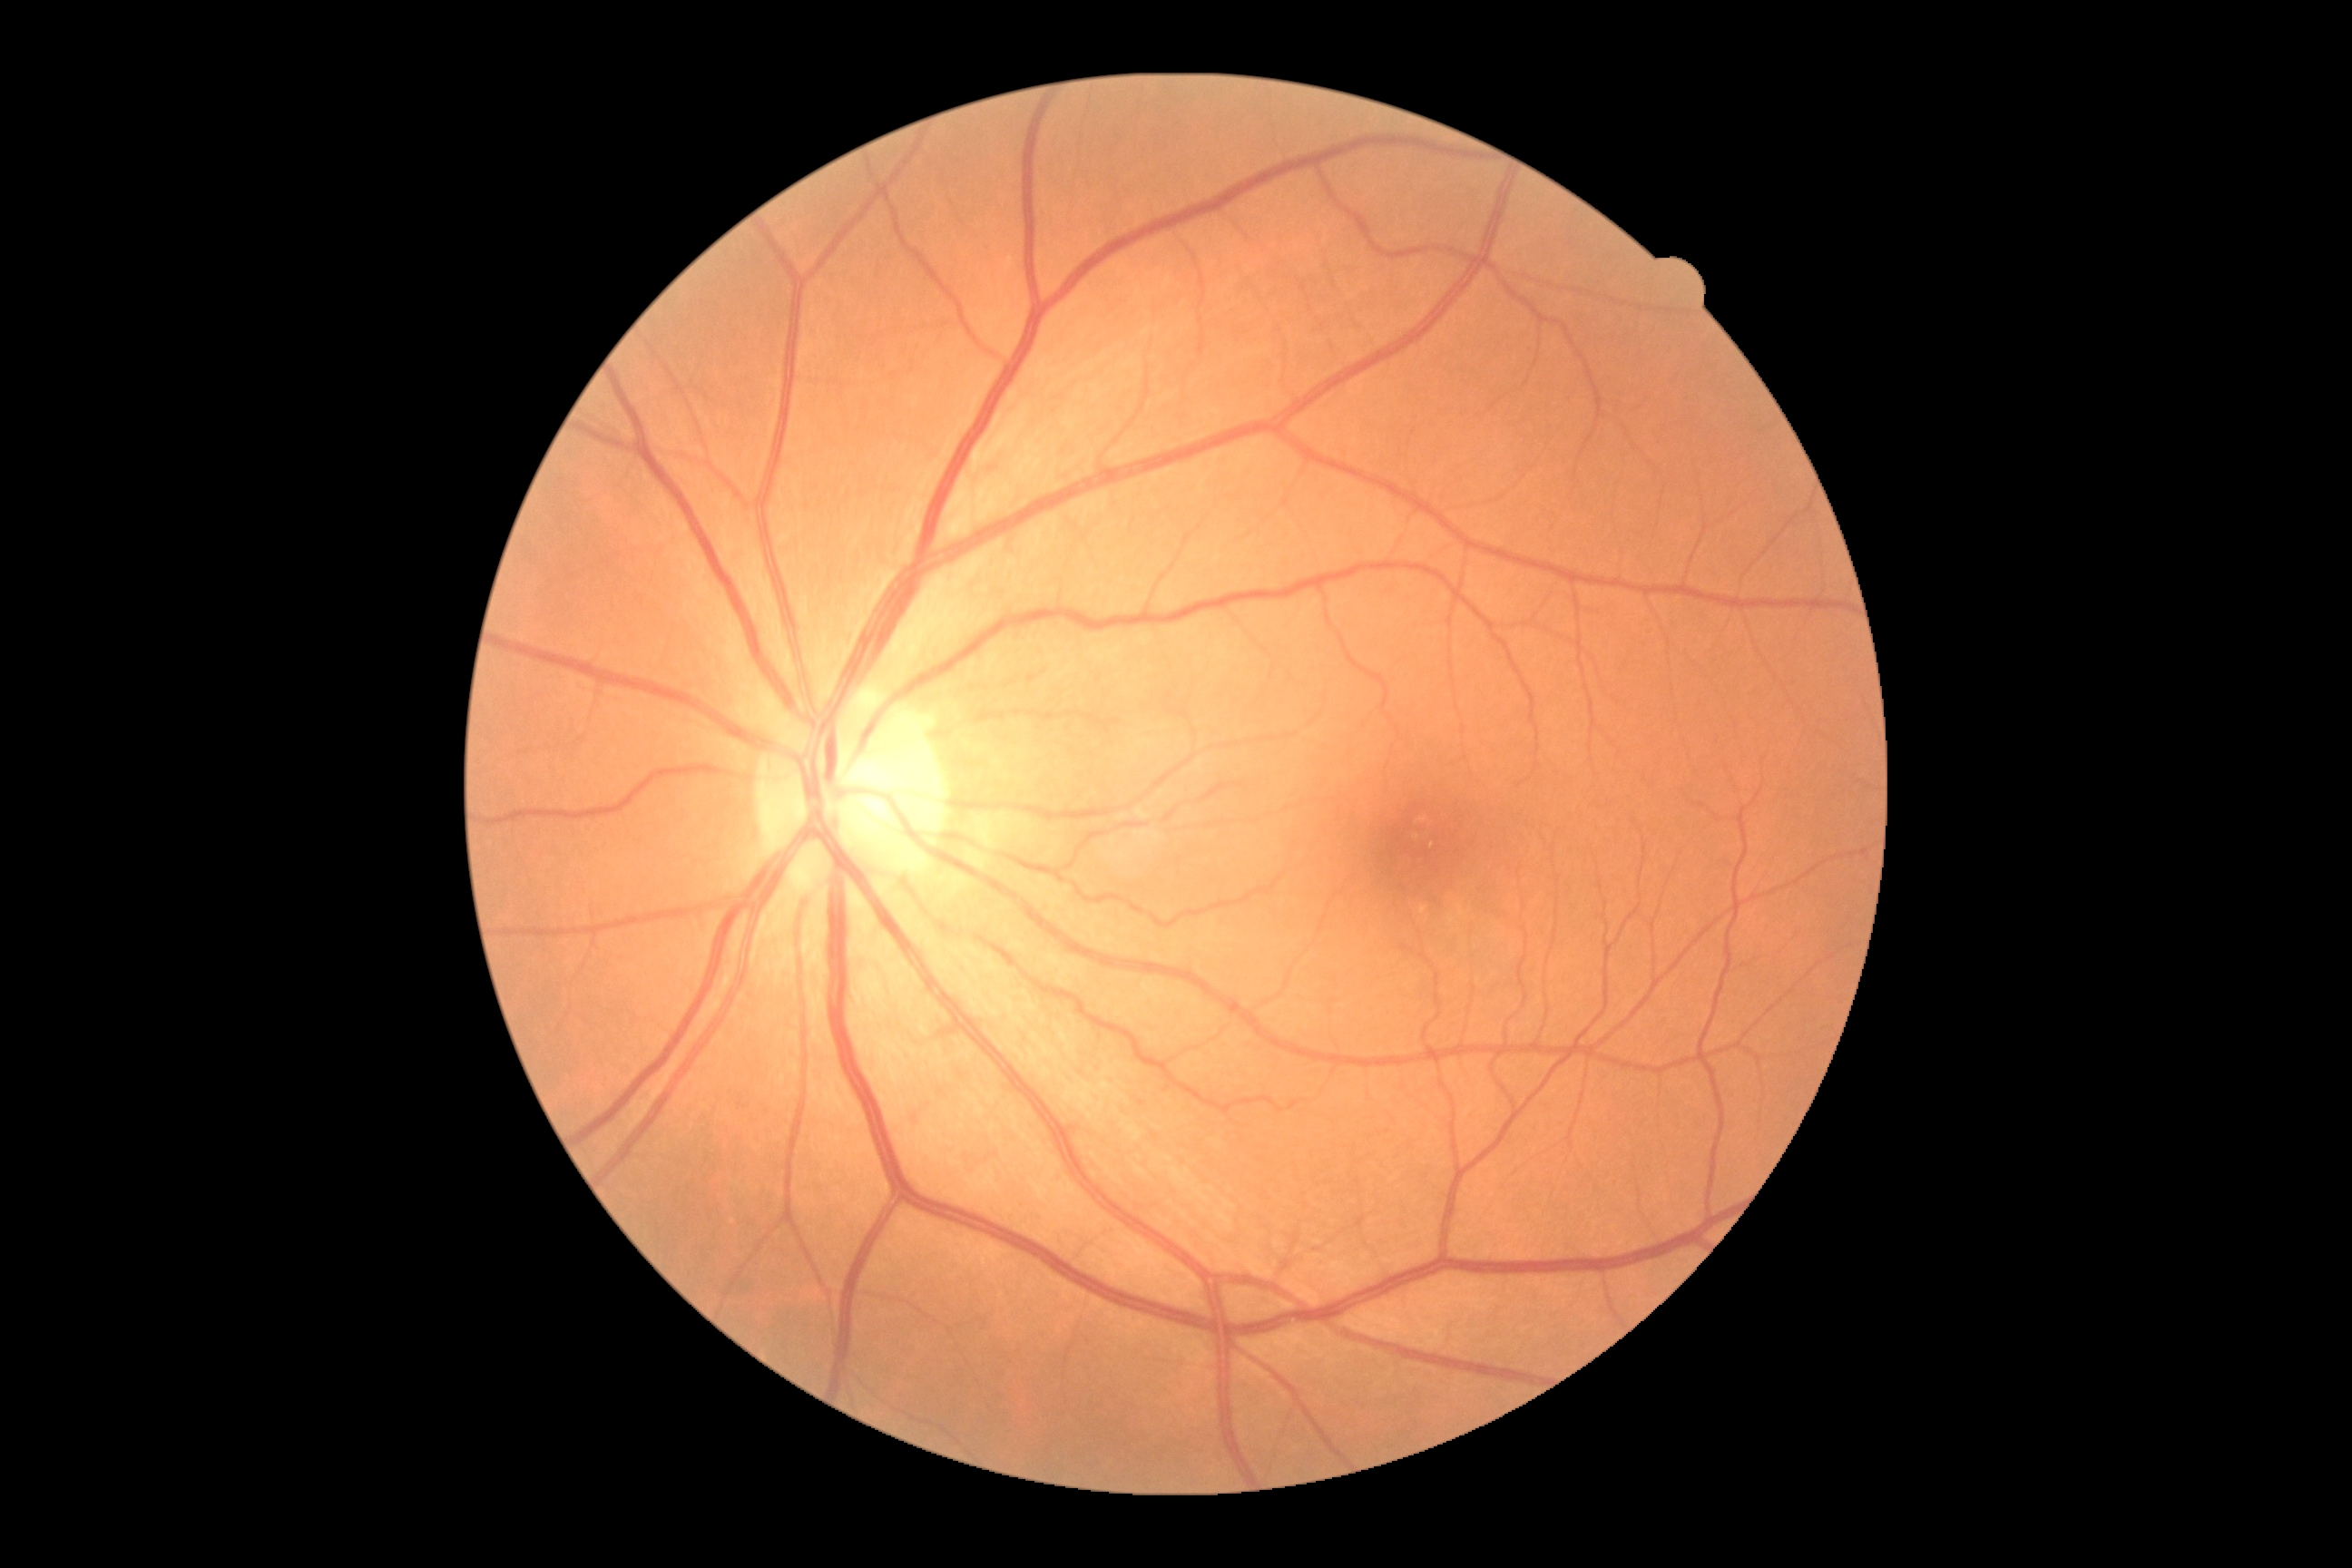
diabetic retinopathy (DR)=no apparent diabetic retinopathy (grade 0), DR impression=no DR findings.